848x848px. Posterior pole photograph. No pharmacologic dilation. NIDEK AFC-230 fundus camera.
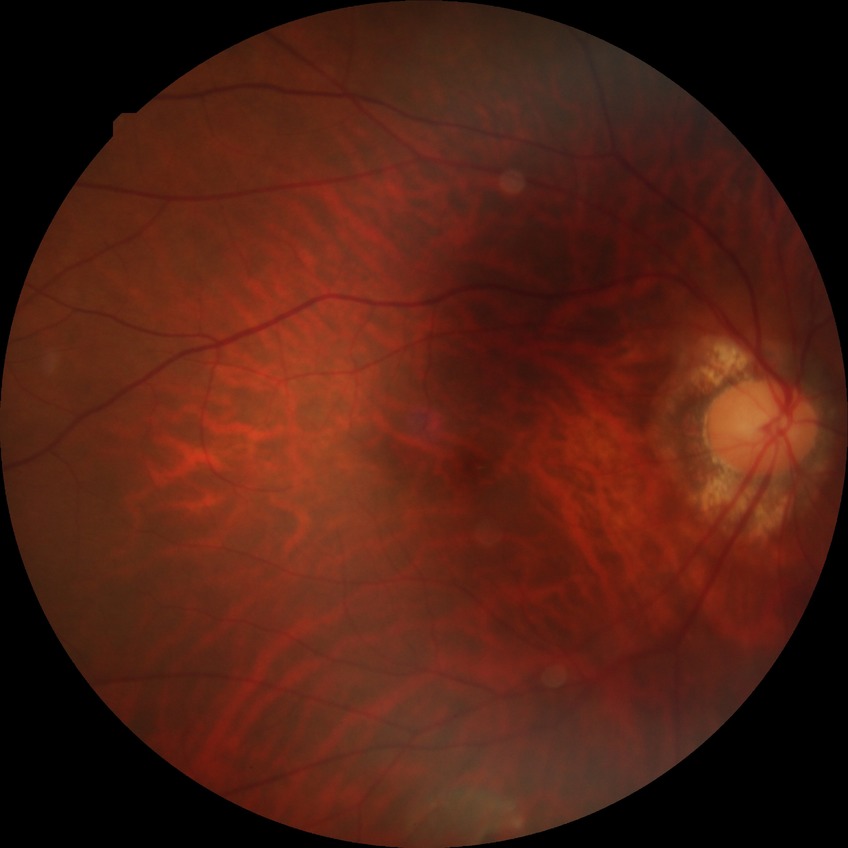
Annotations:
– modified Davis classification — no diabetic retinopathy